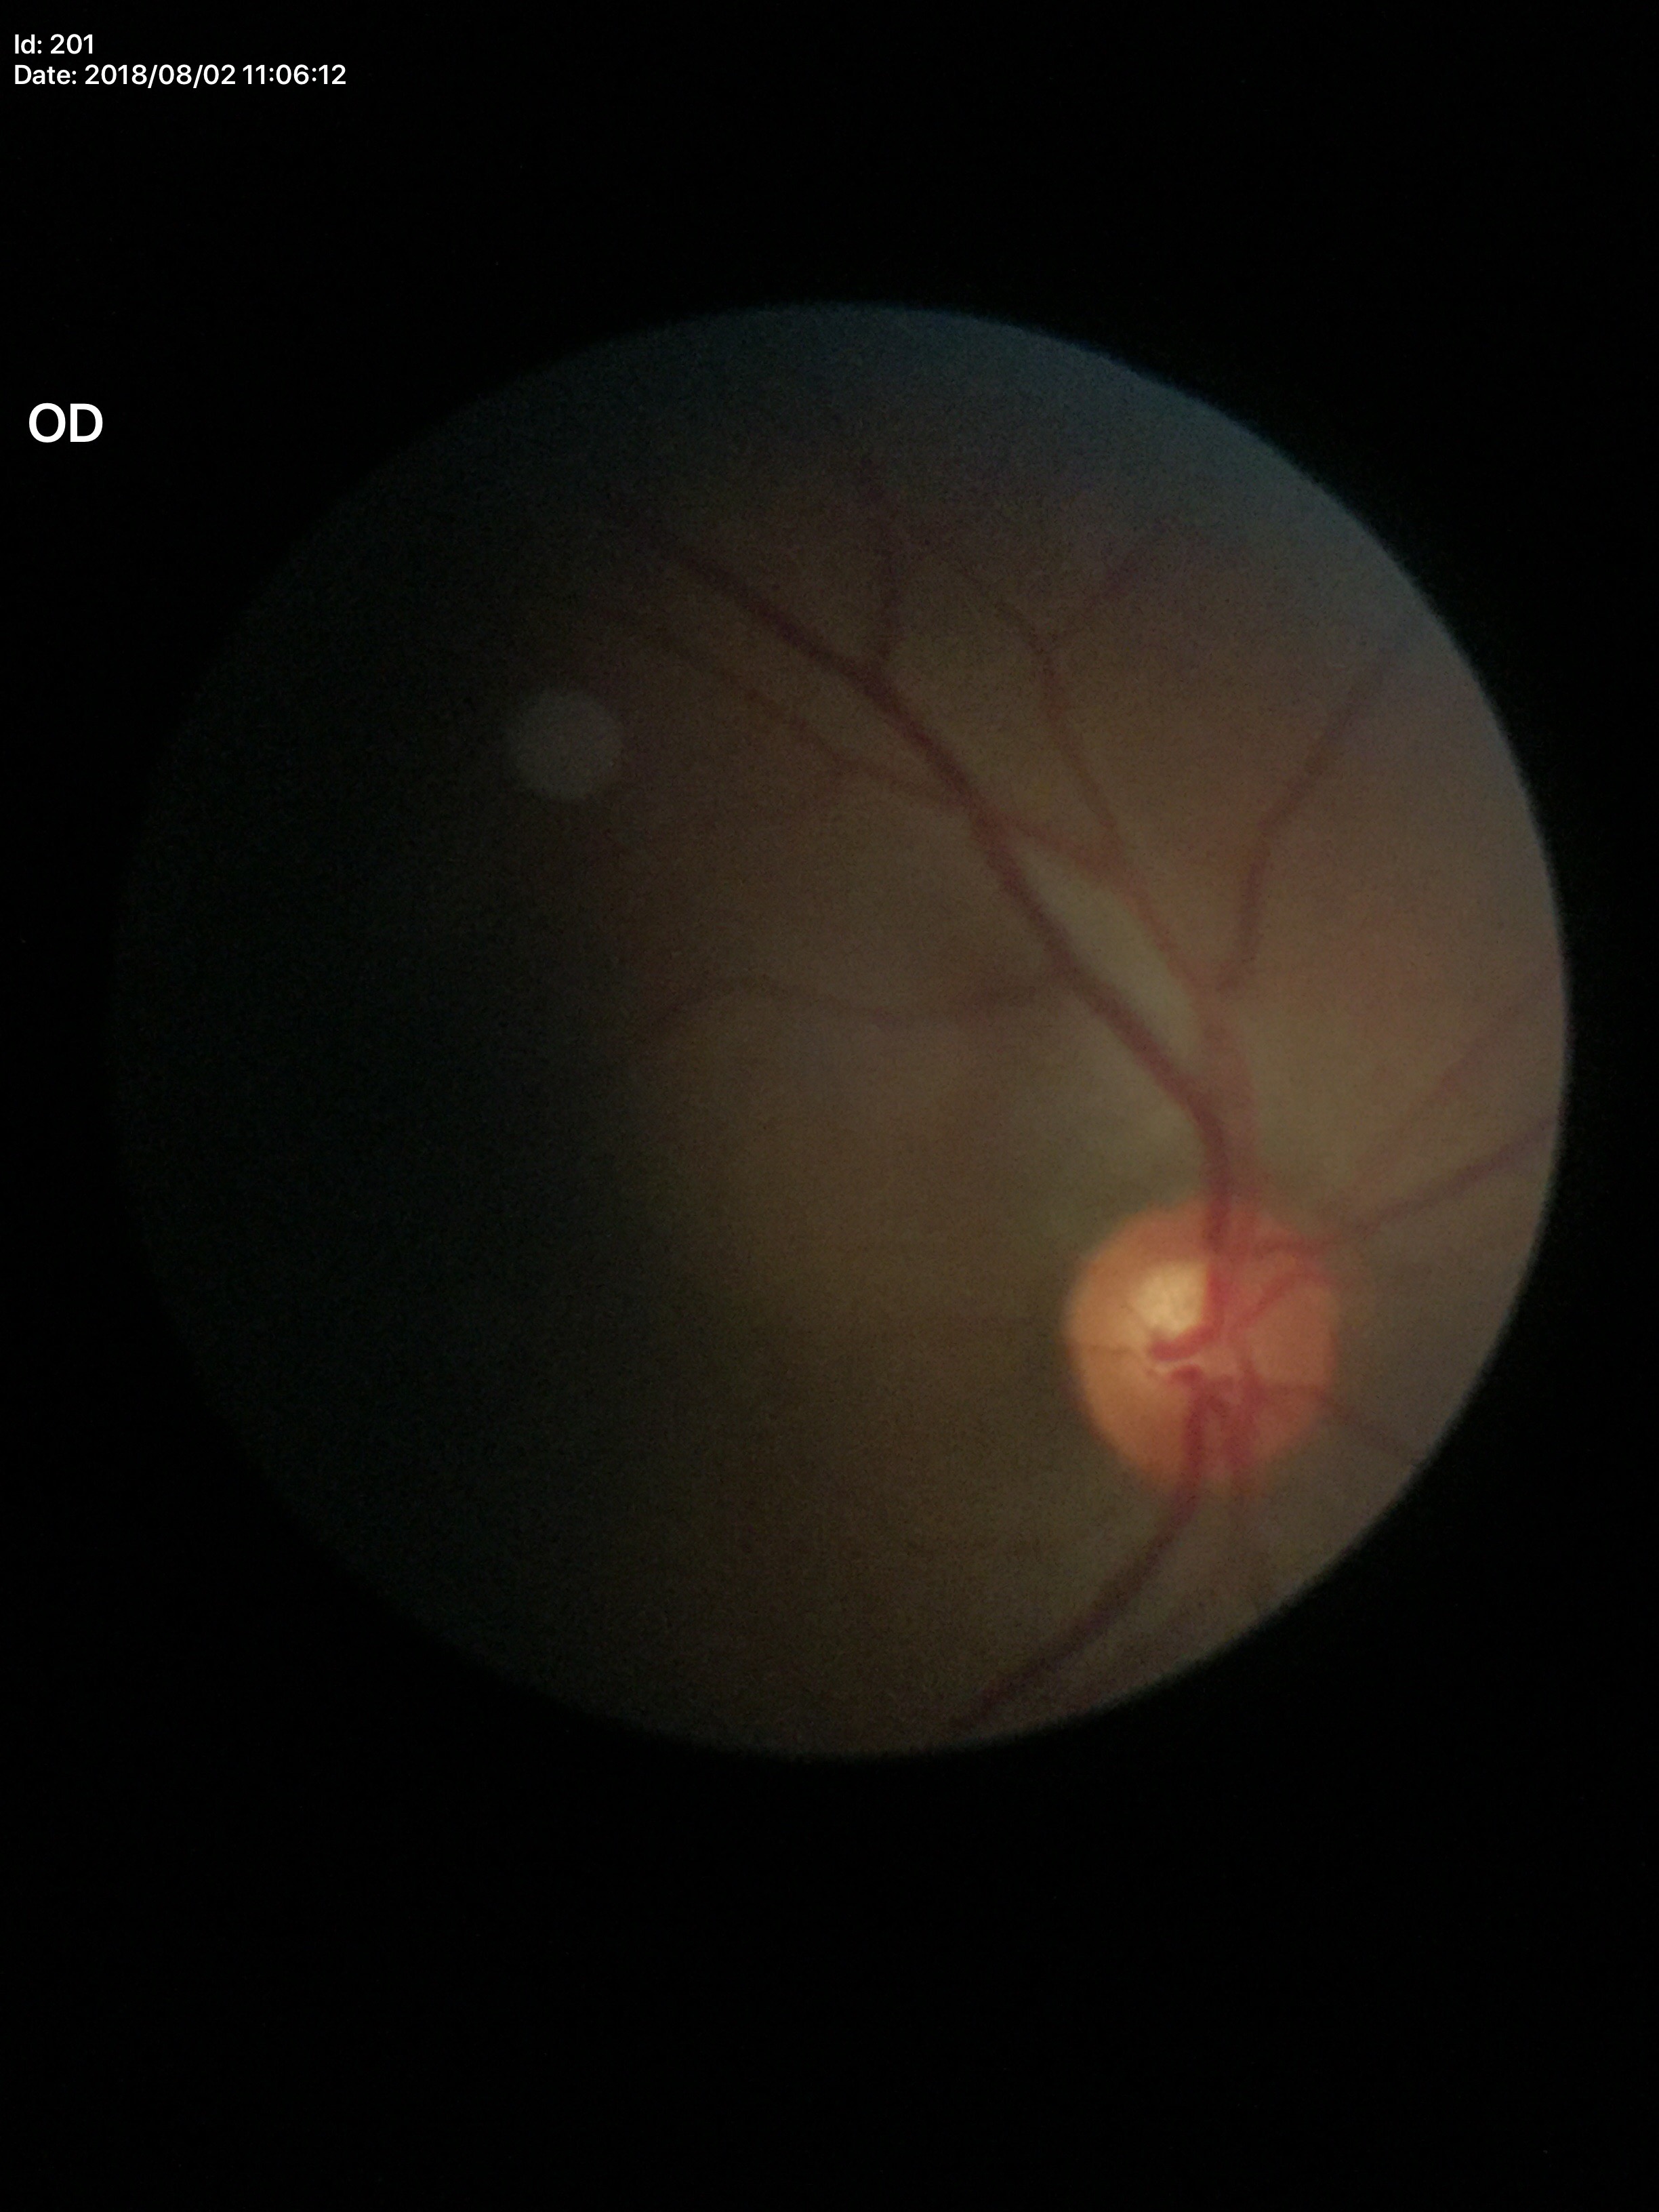

Annotations:
* Glaucoma screening impression · no suspicious findings
* area CDR · 0.30
* vertical cup-to-disc ratio · 0.55